Posterior pole photograph, modified Davis classification.
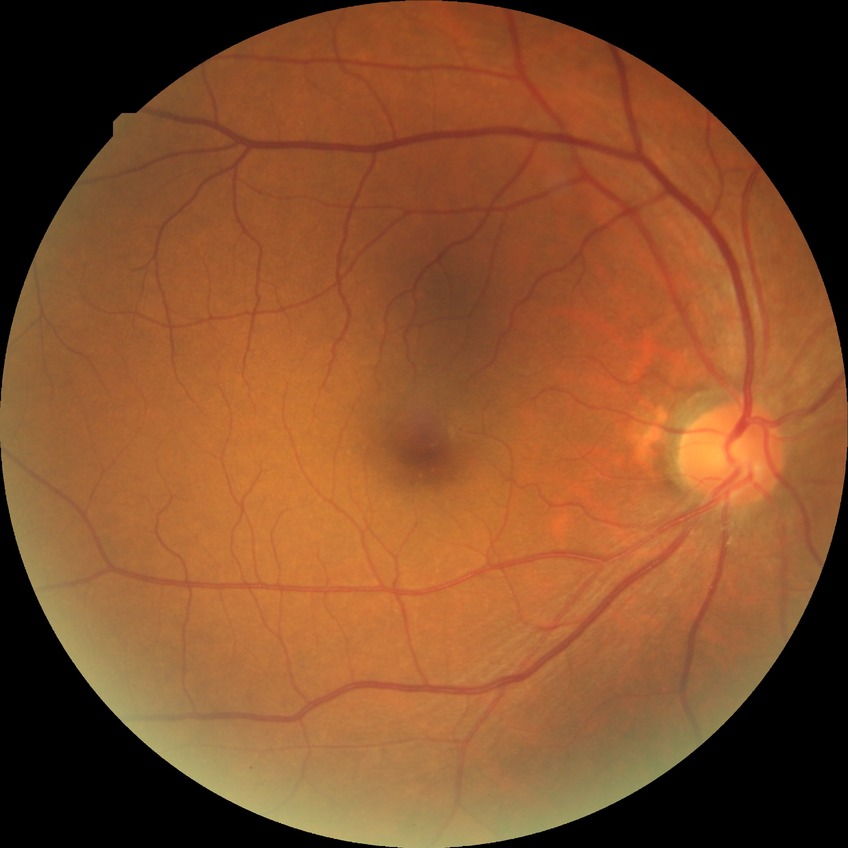
Modified Davis grade: NDR. No diabetic retinal disease findings.